NIDEK AFC-230.
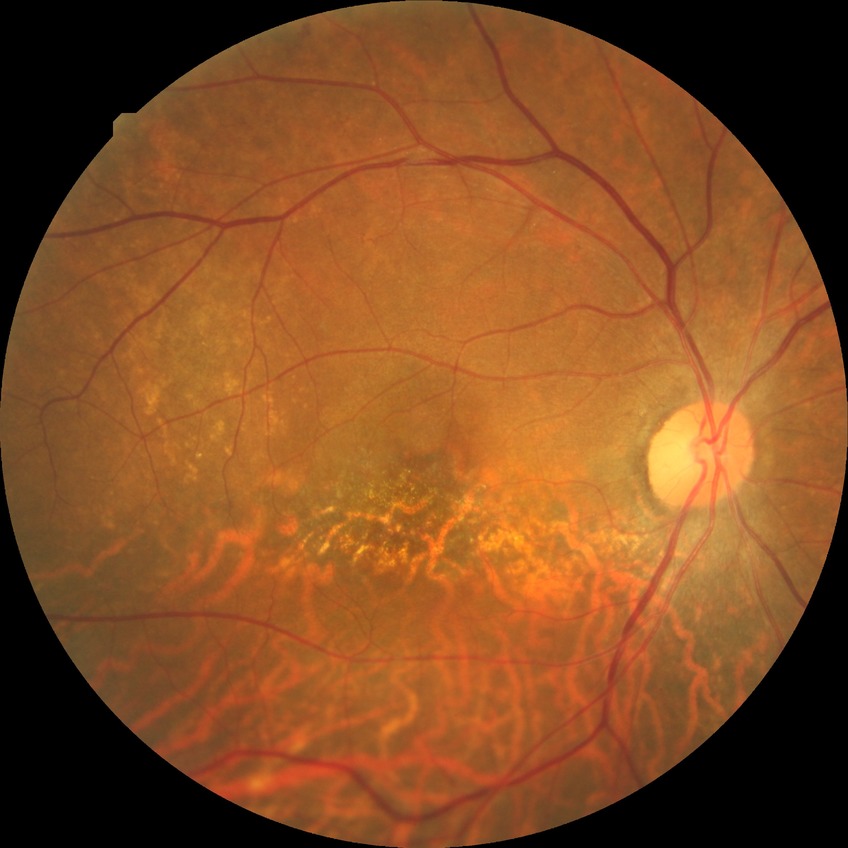

DR severity: NDR.